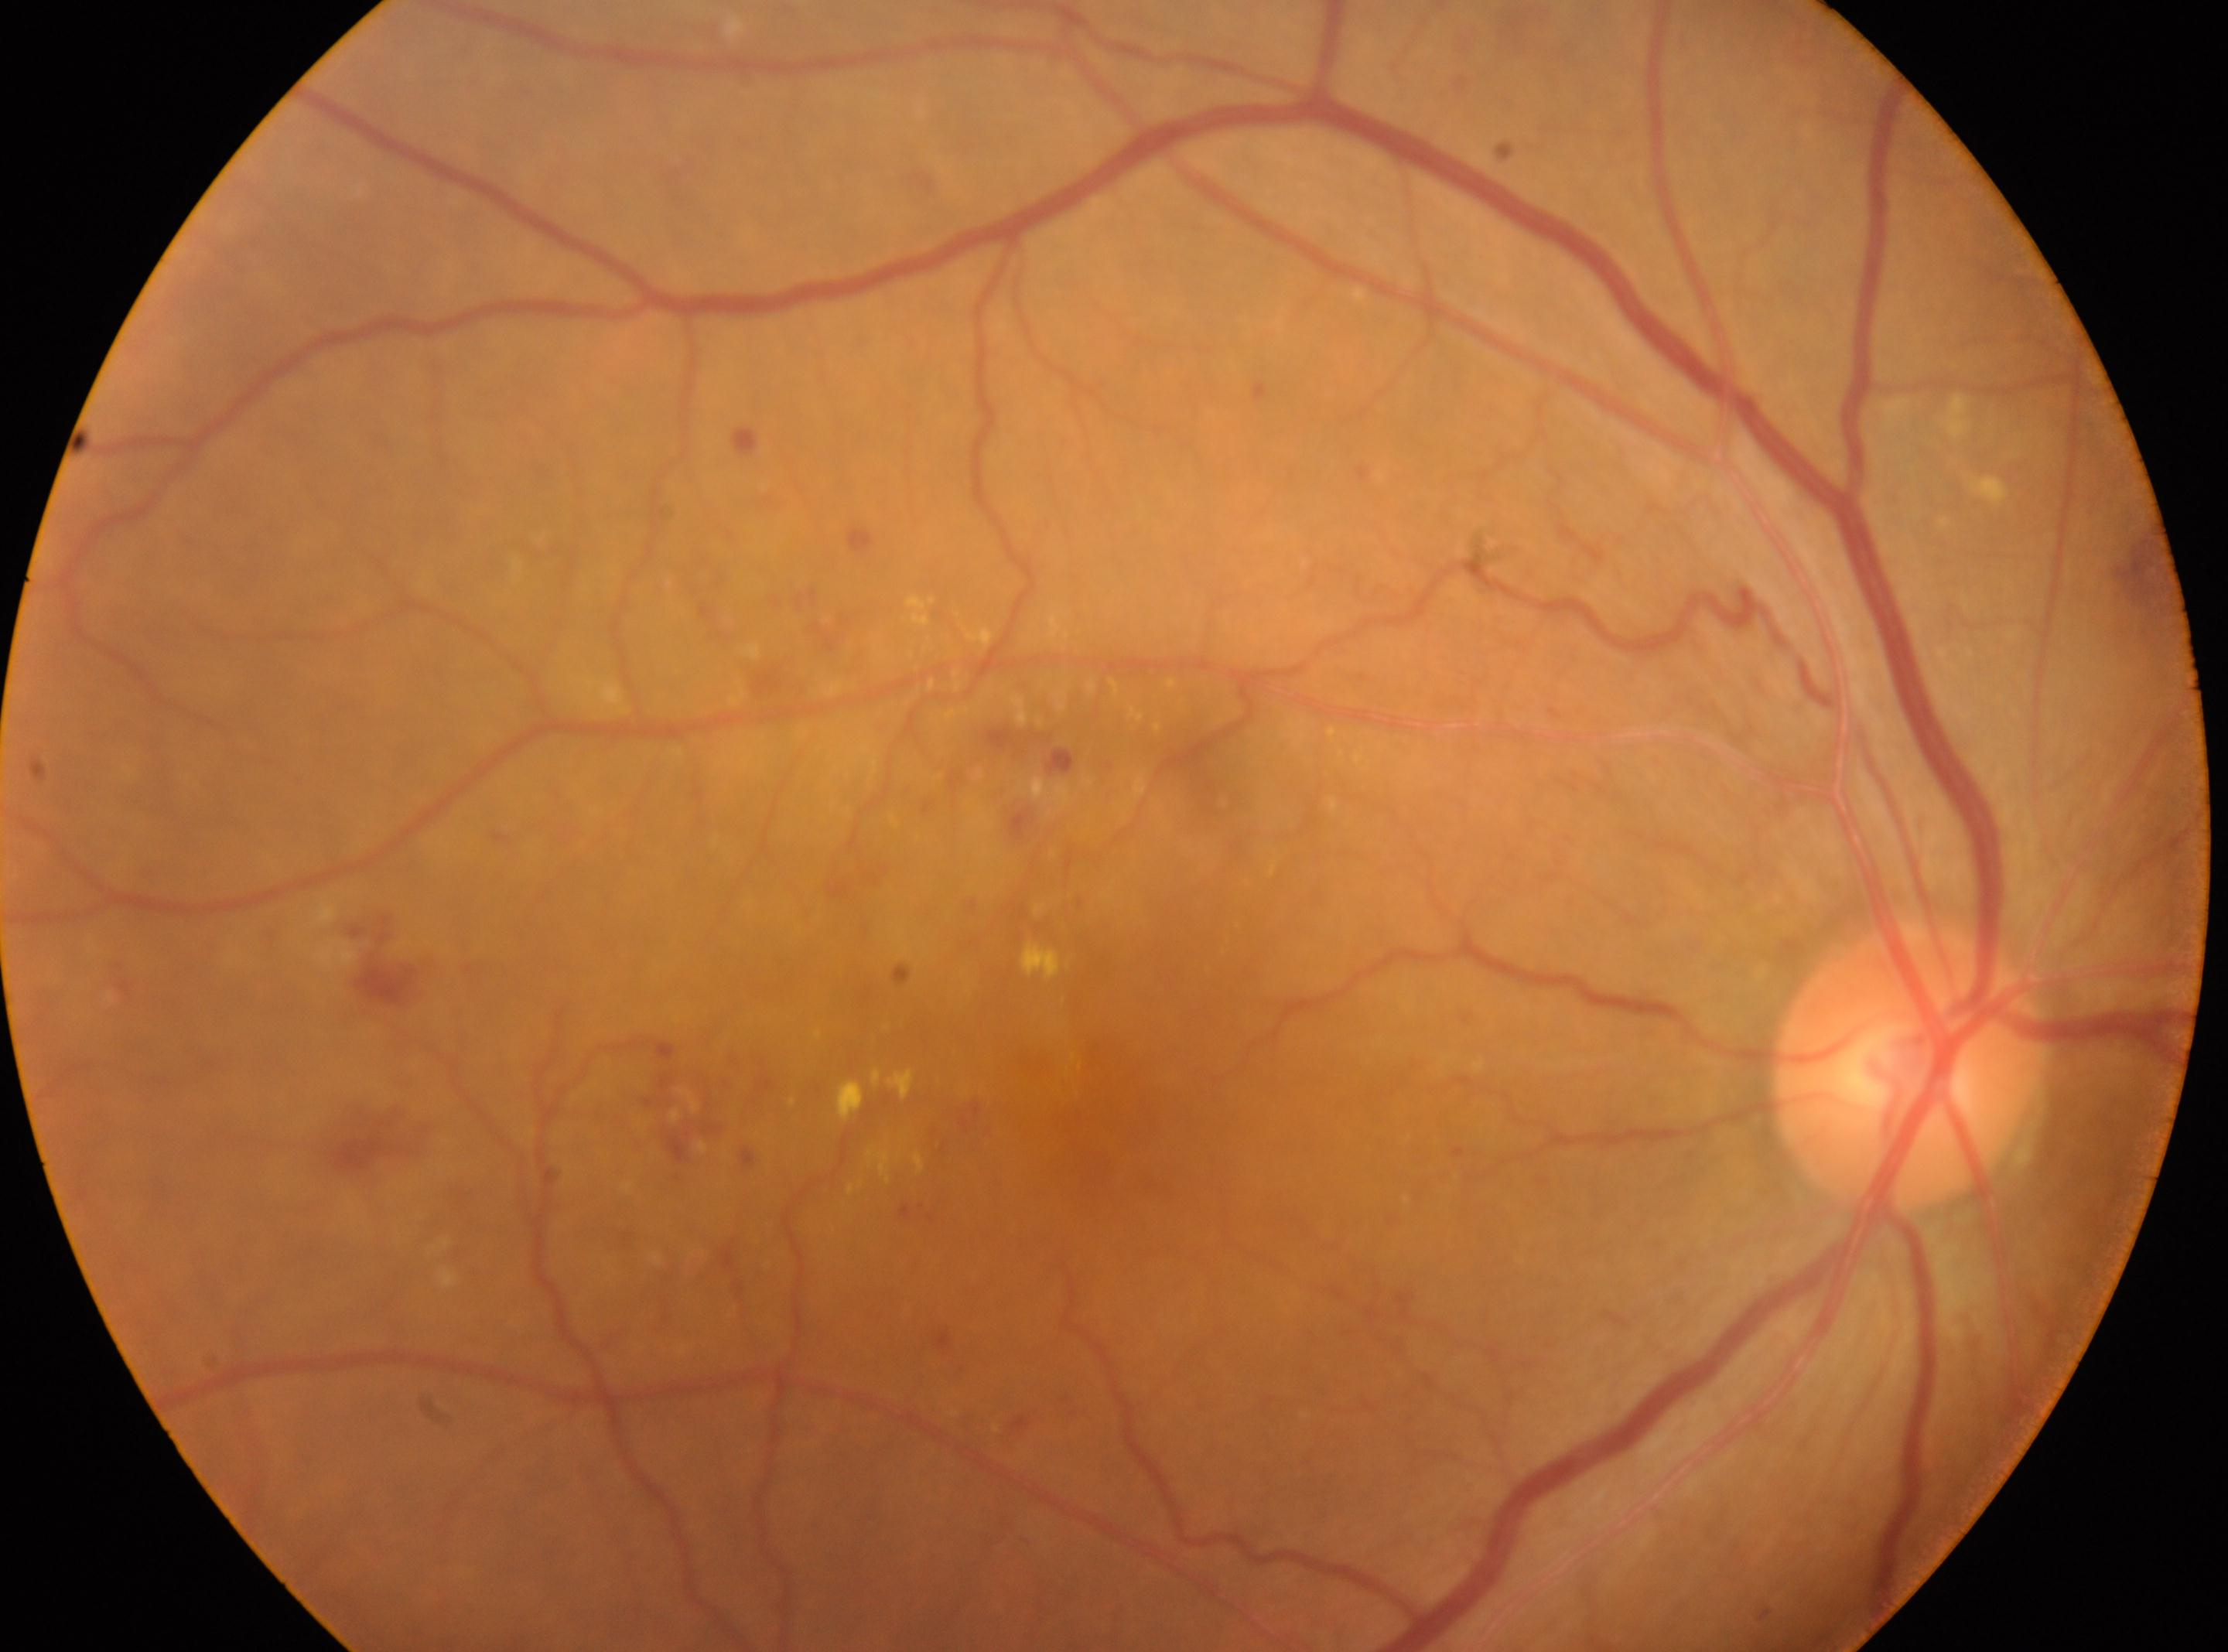

diabetic retinopathy (DR)=2/4 — more than just microaneurysms but less than severe NPDR | non-proliferative diabetic retinopathy | optic disc=(x=1908, y=1071) | fovea center=(x=1088, y=1125) | right.